1380x1382: 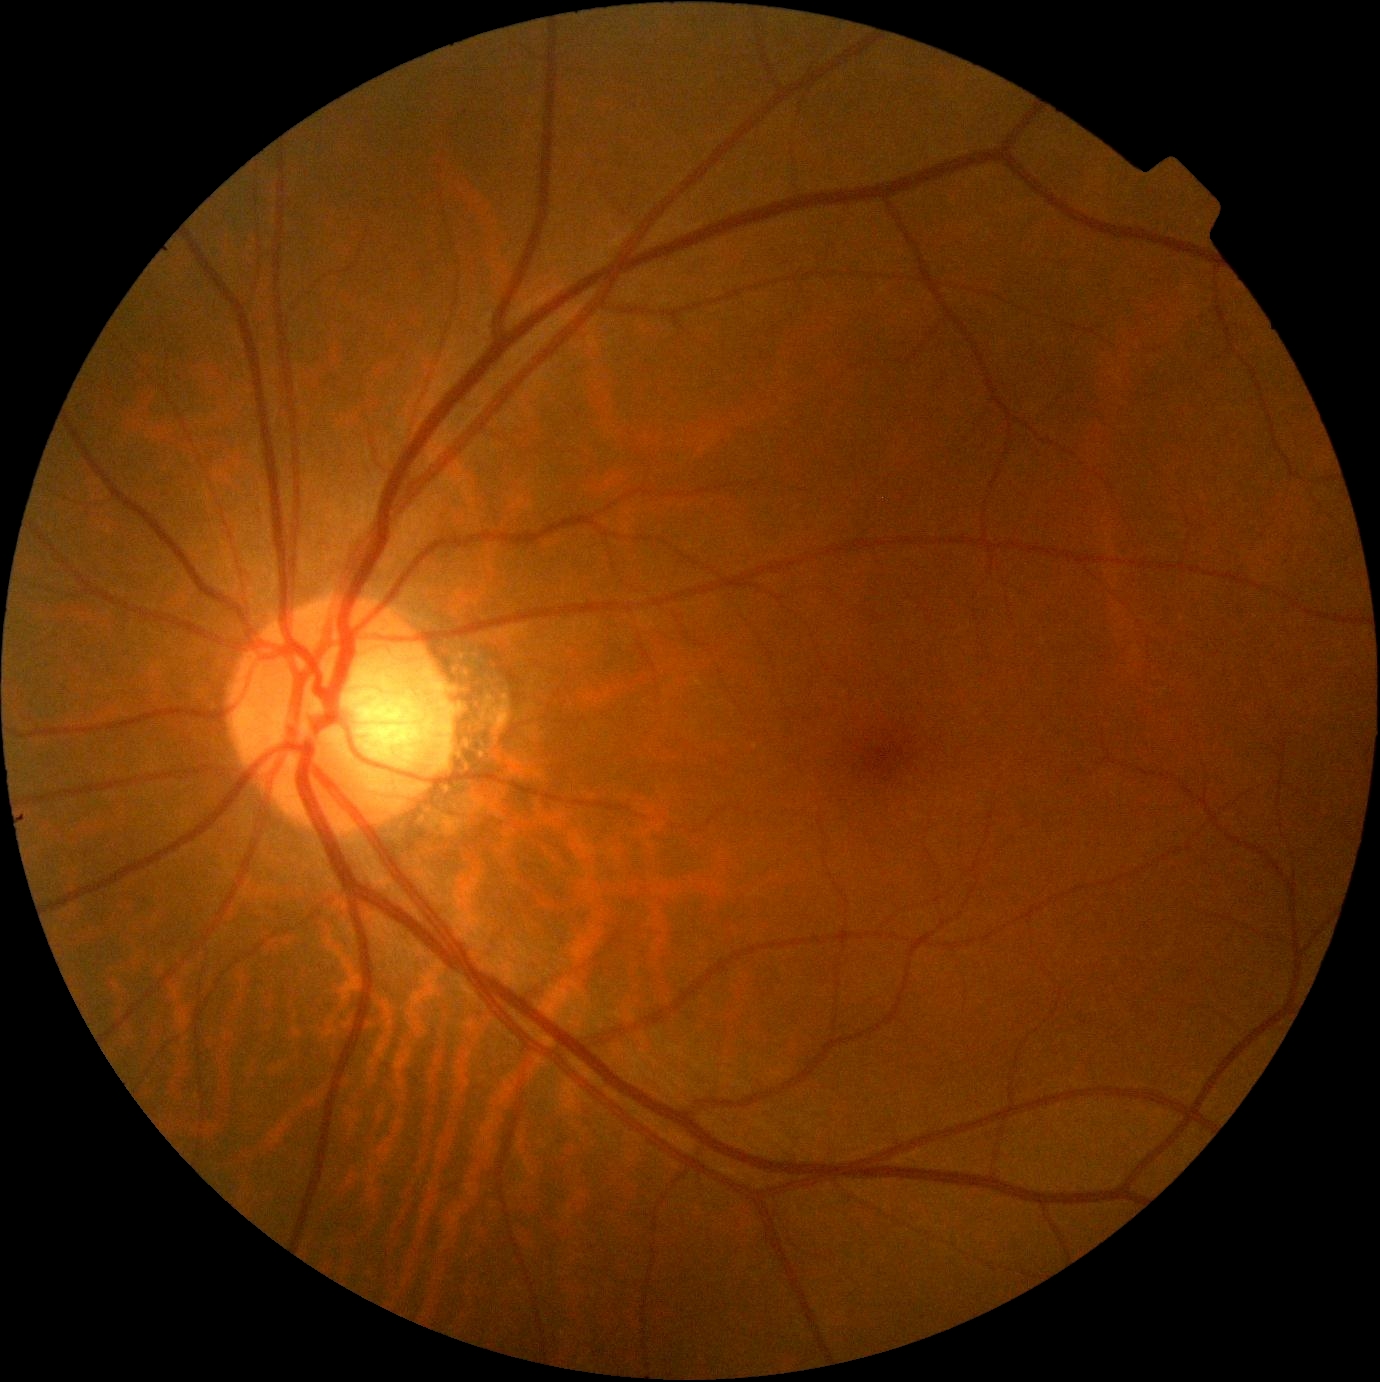
Diabetic retinopathy (DR): grade 0 (no apparent retinopathy) — no visible signs of diabetic retinopathy.